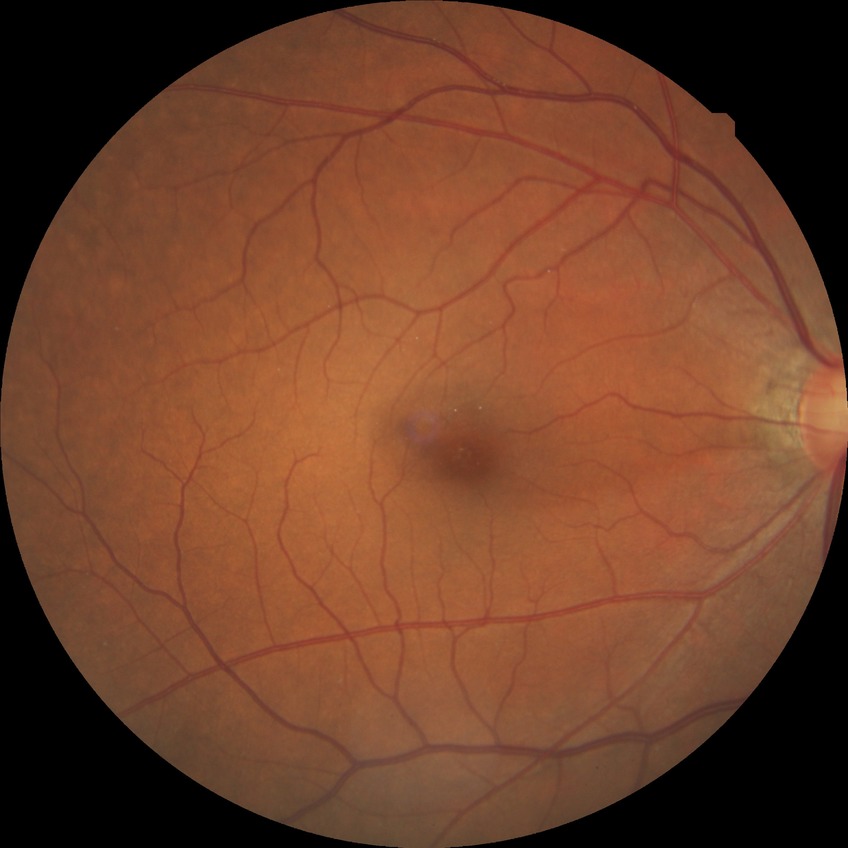 Diabetic retinopathy severity is no diabetic retinopathy.